Fundus photo: 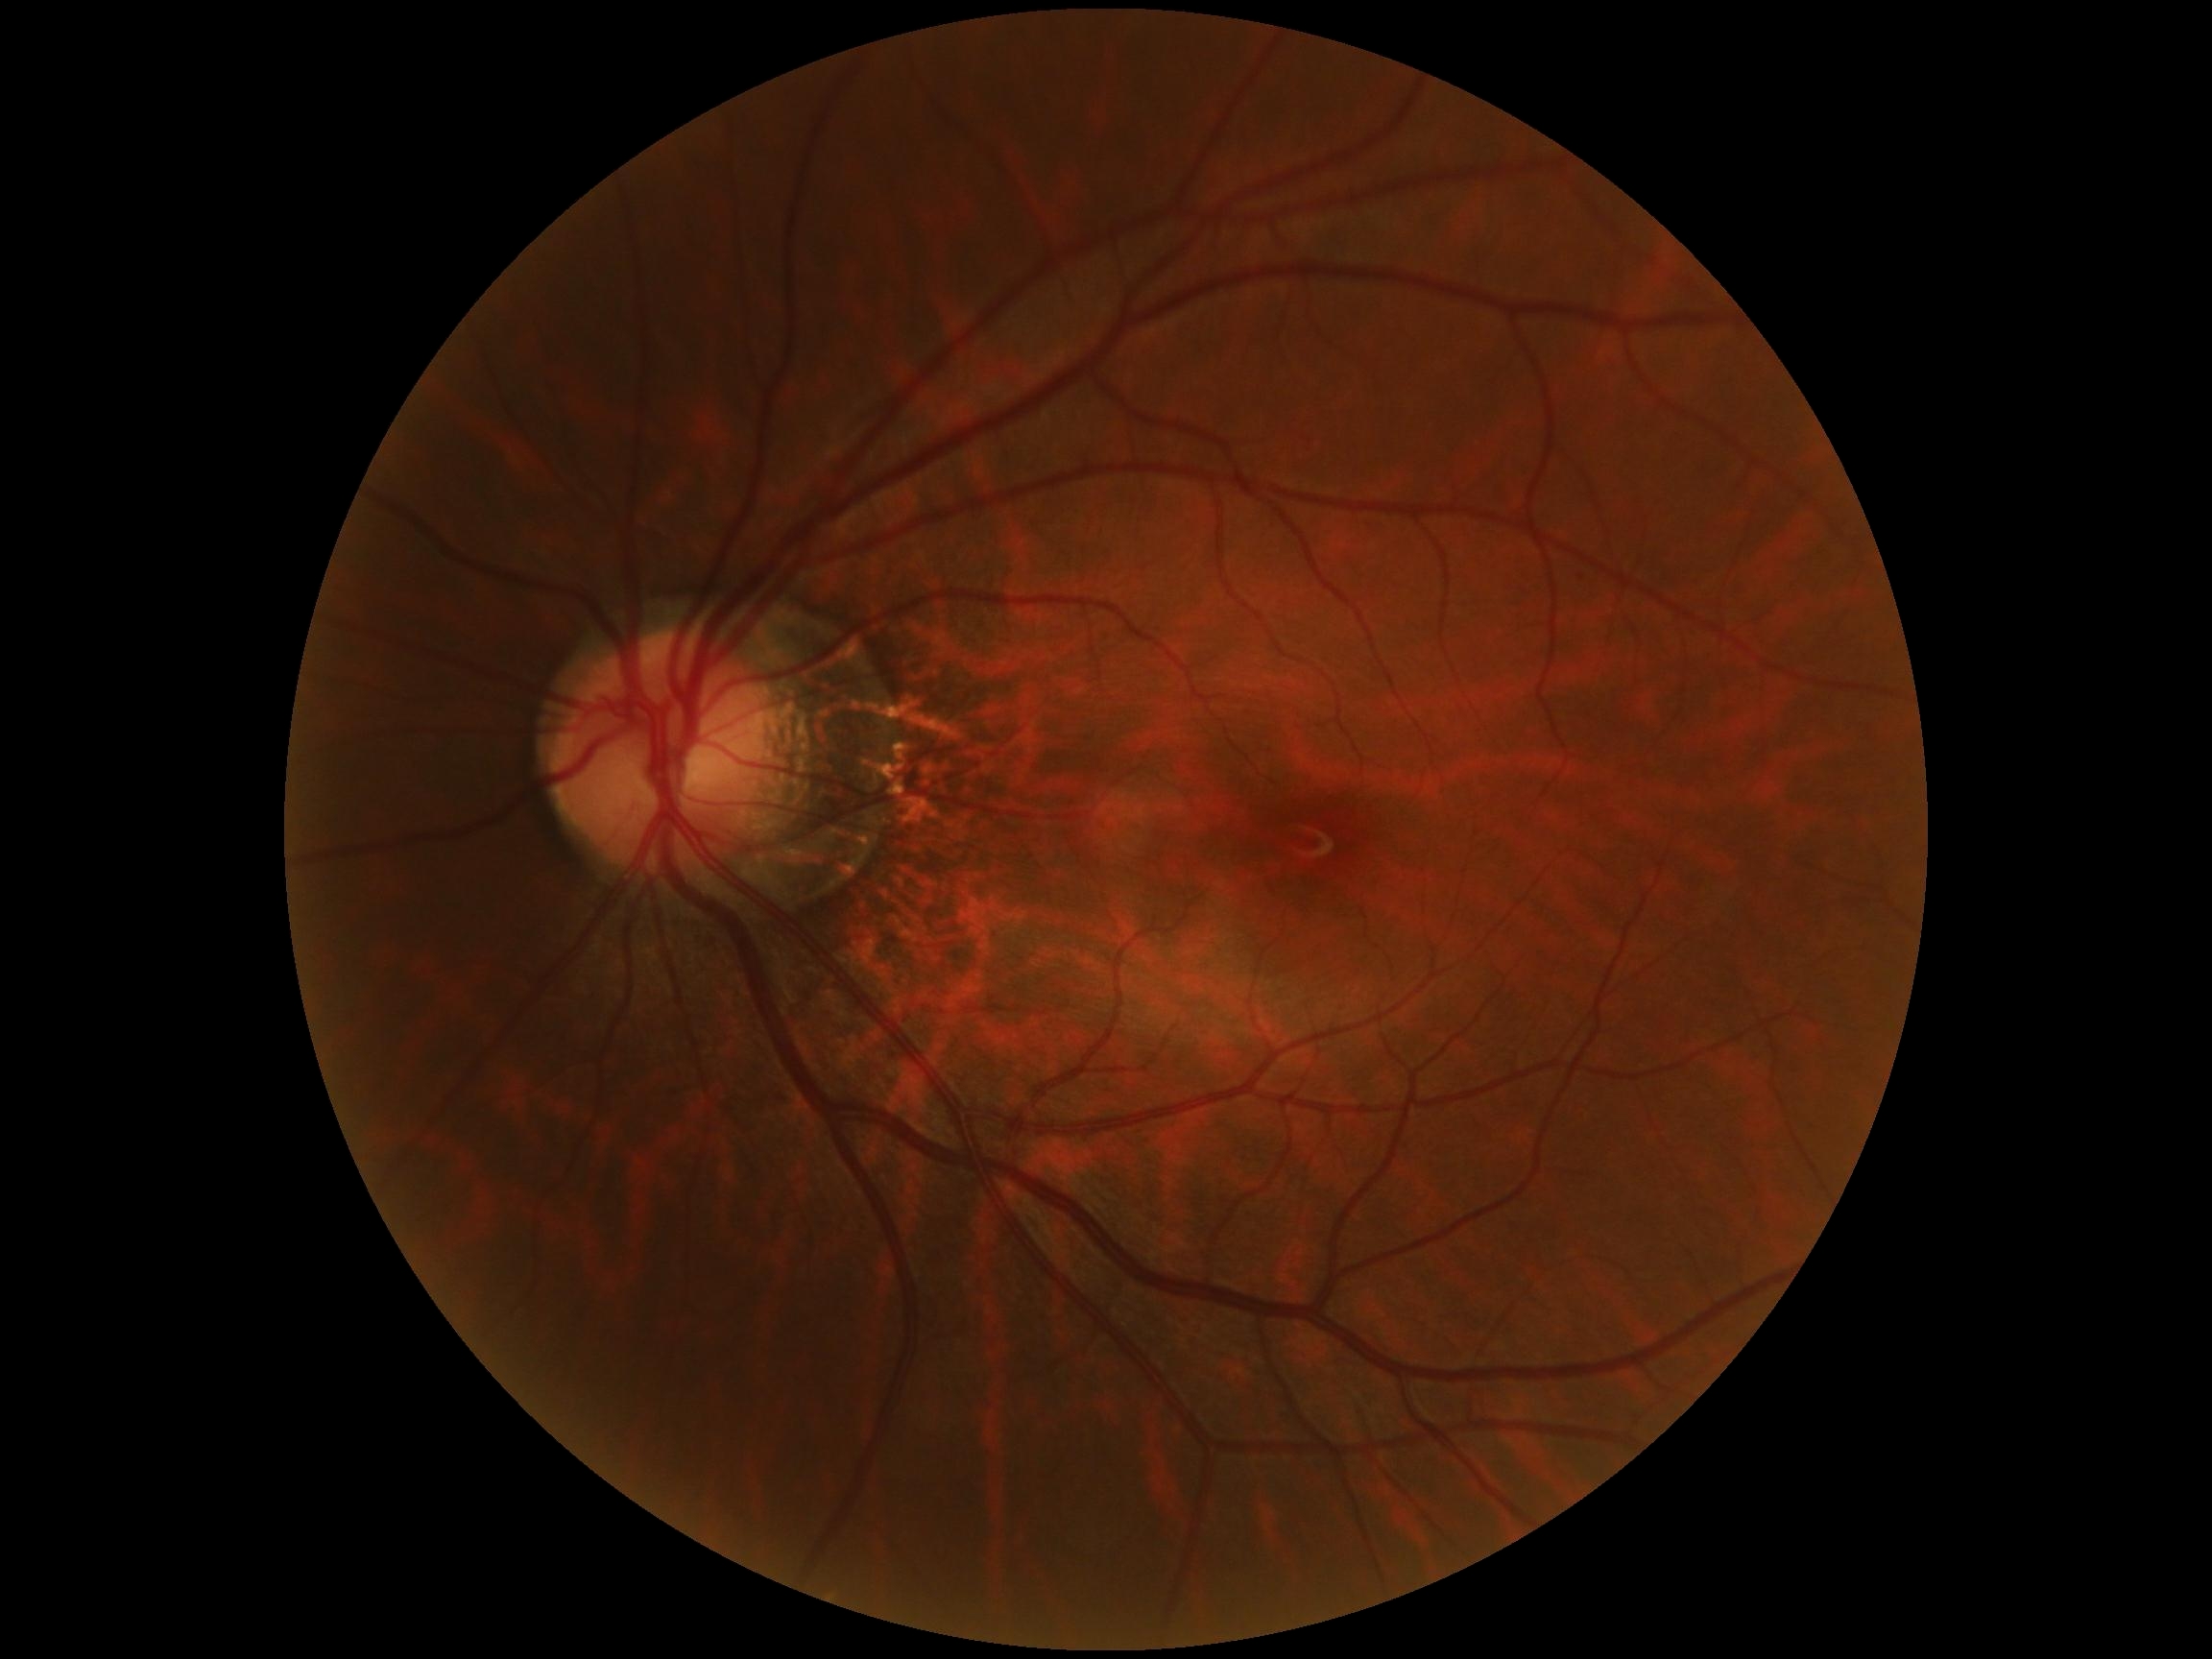
{"dr_grade": "0/4"}